Infant wide-field fundus photograph · image size 640x480
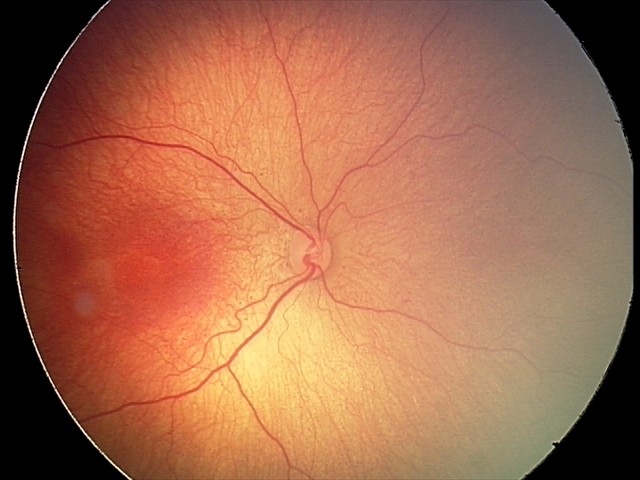

Without plus disease. Screening examination consistent with retinopathy of prematurity stage 2 — ridge with height and width at the demarcation line.